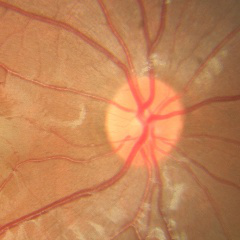

Optic disc photograph demonstrating no glaucomatous changes.